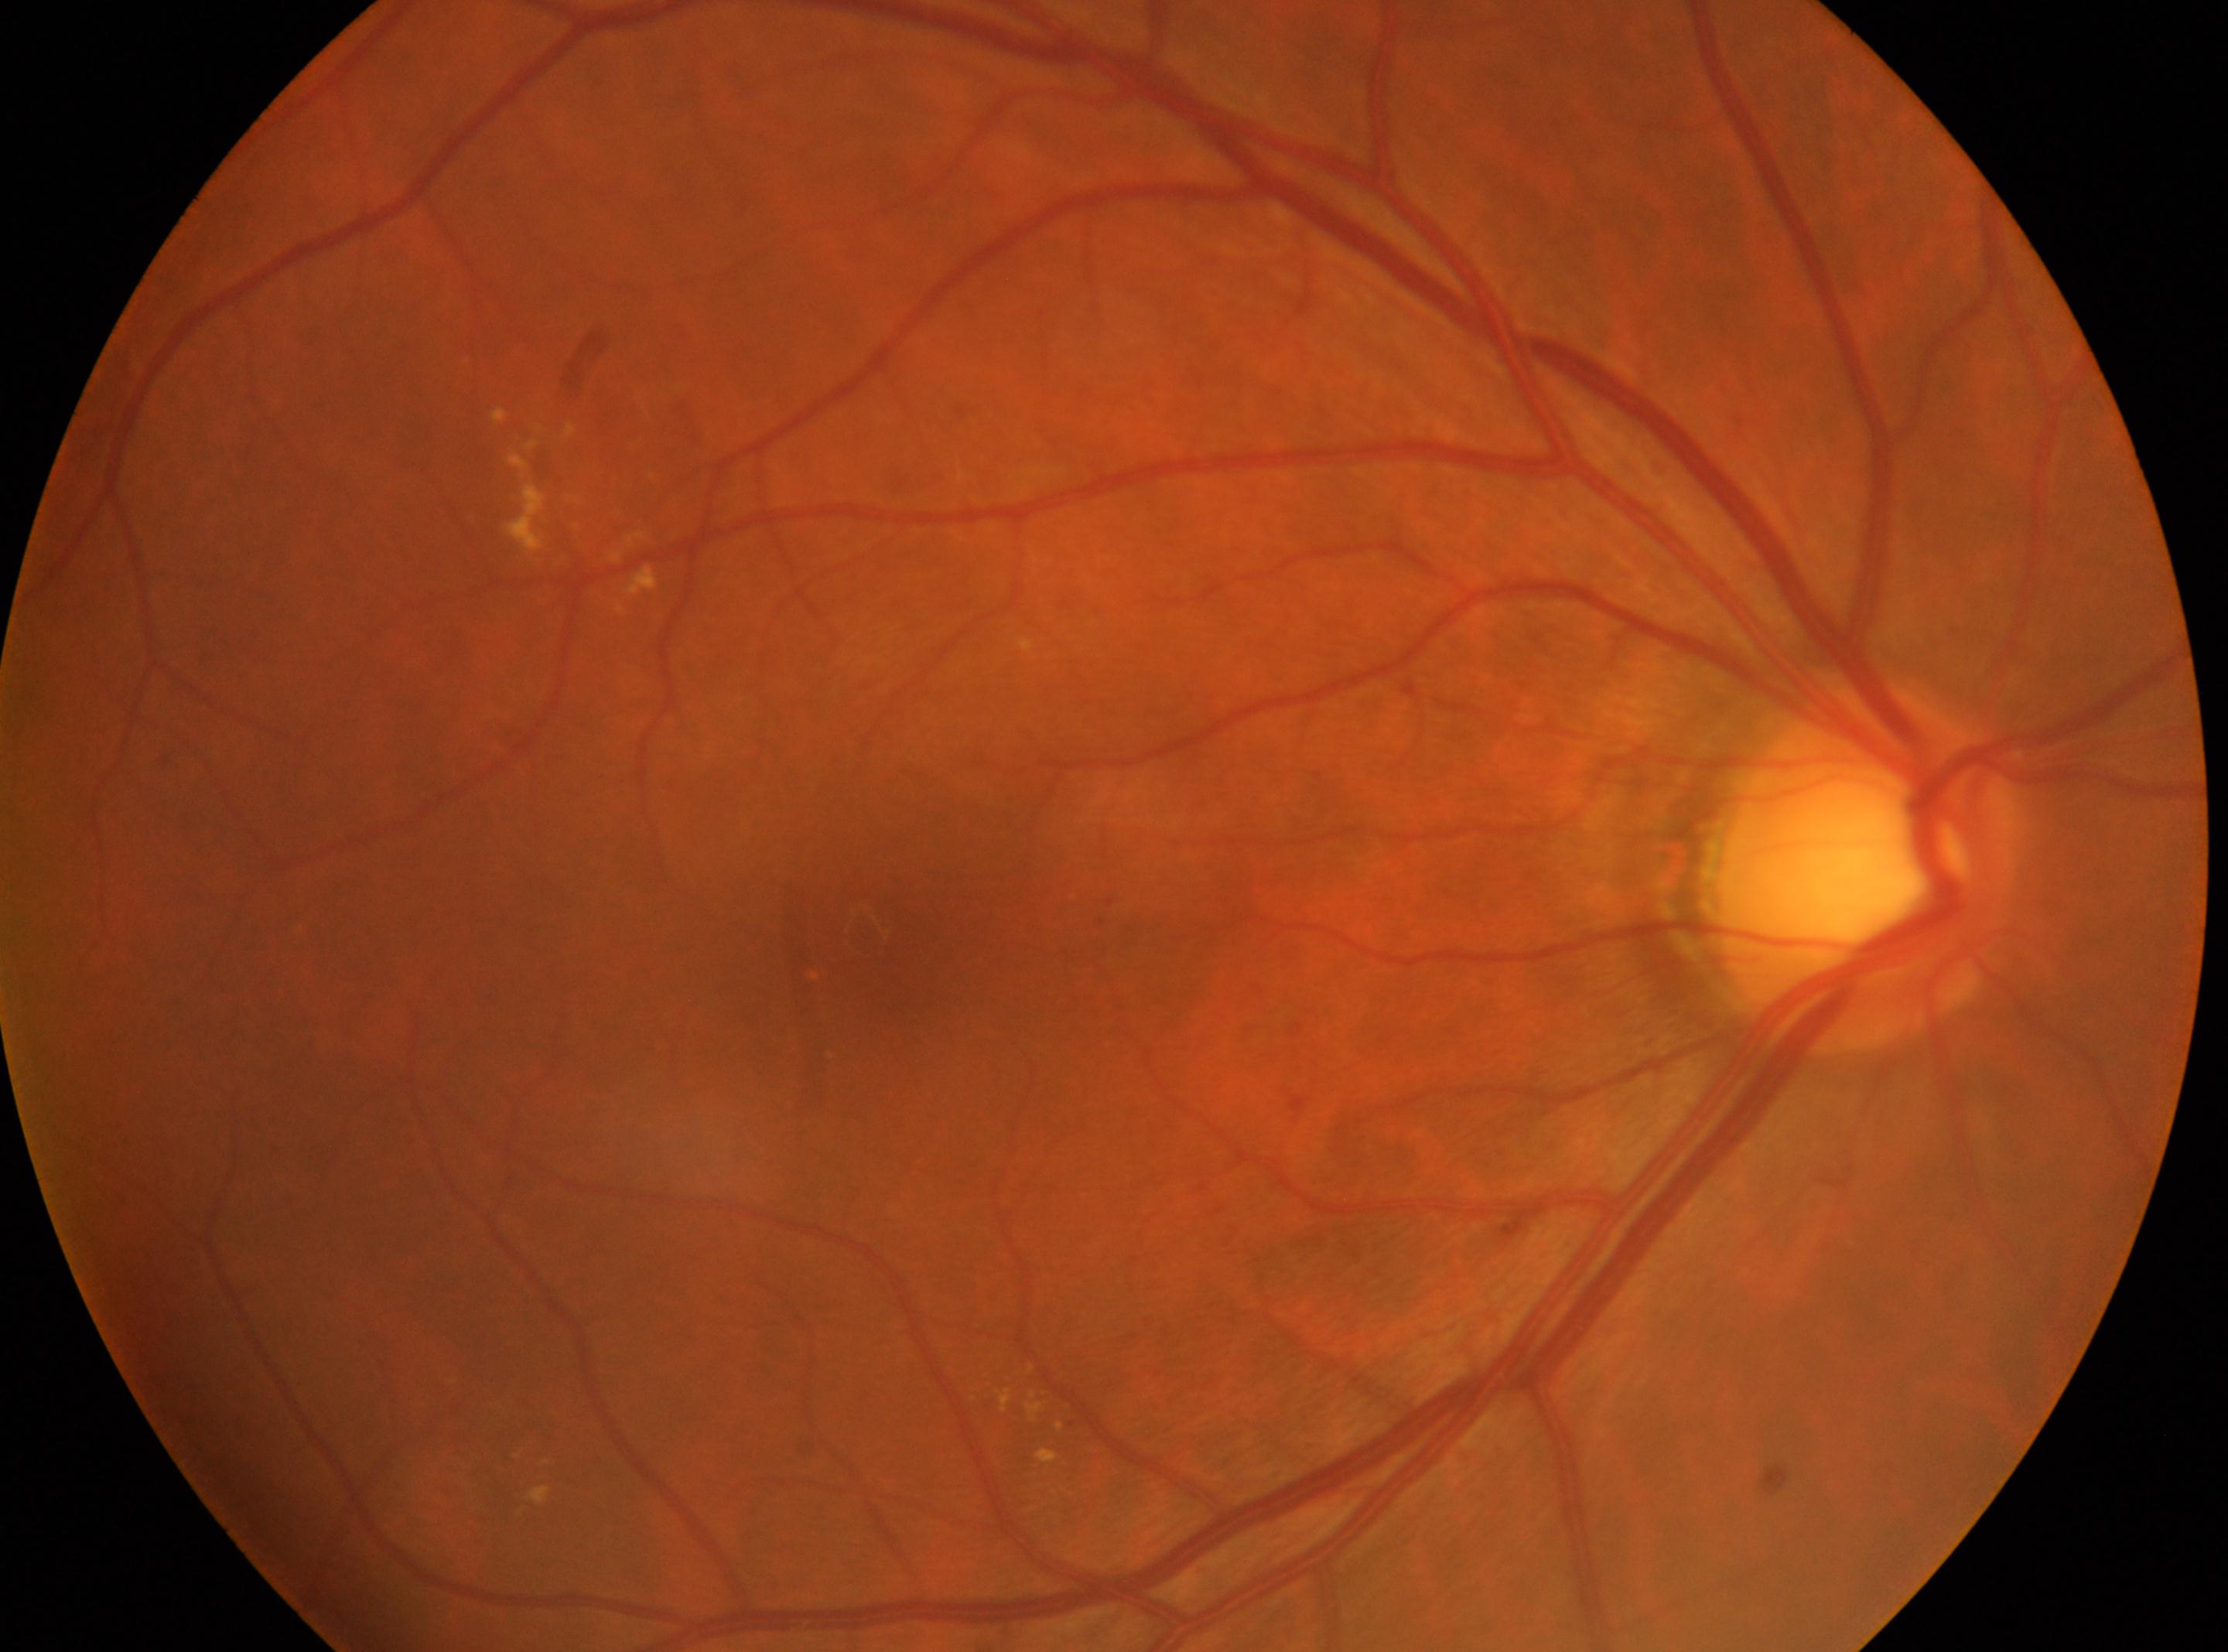 The fovea is at [863, 925]. Imaged eye: right. Diabetic retinopathy is grade 2 (moderate NPDR). Disc center located at [1865, 866].